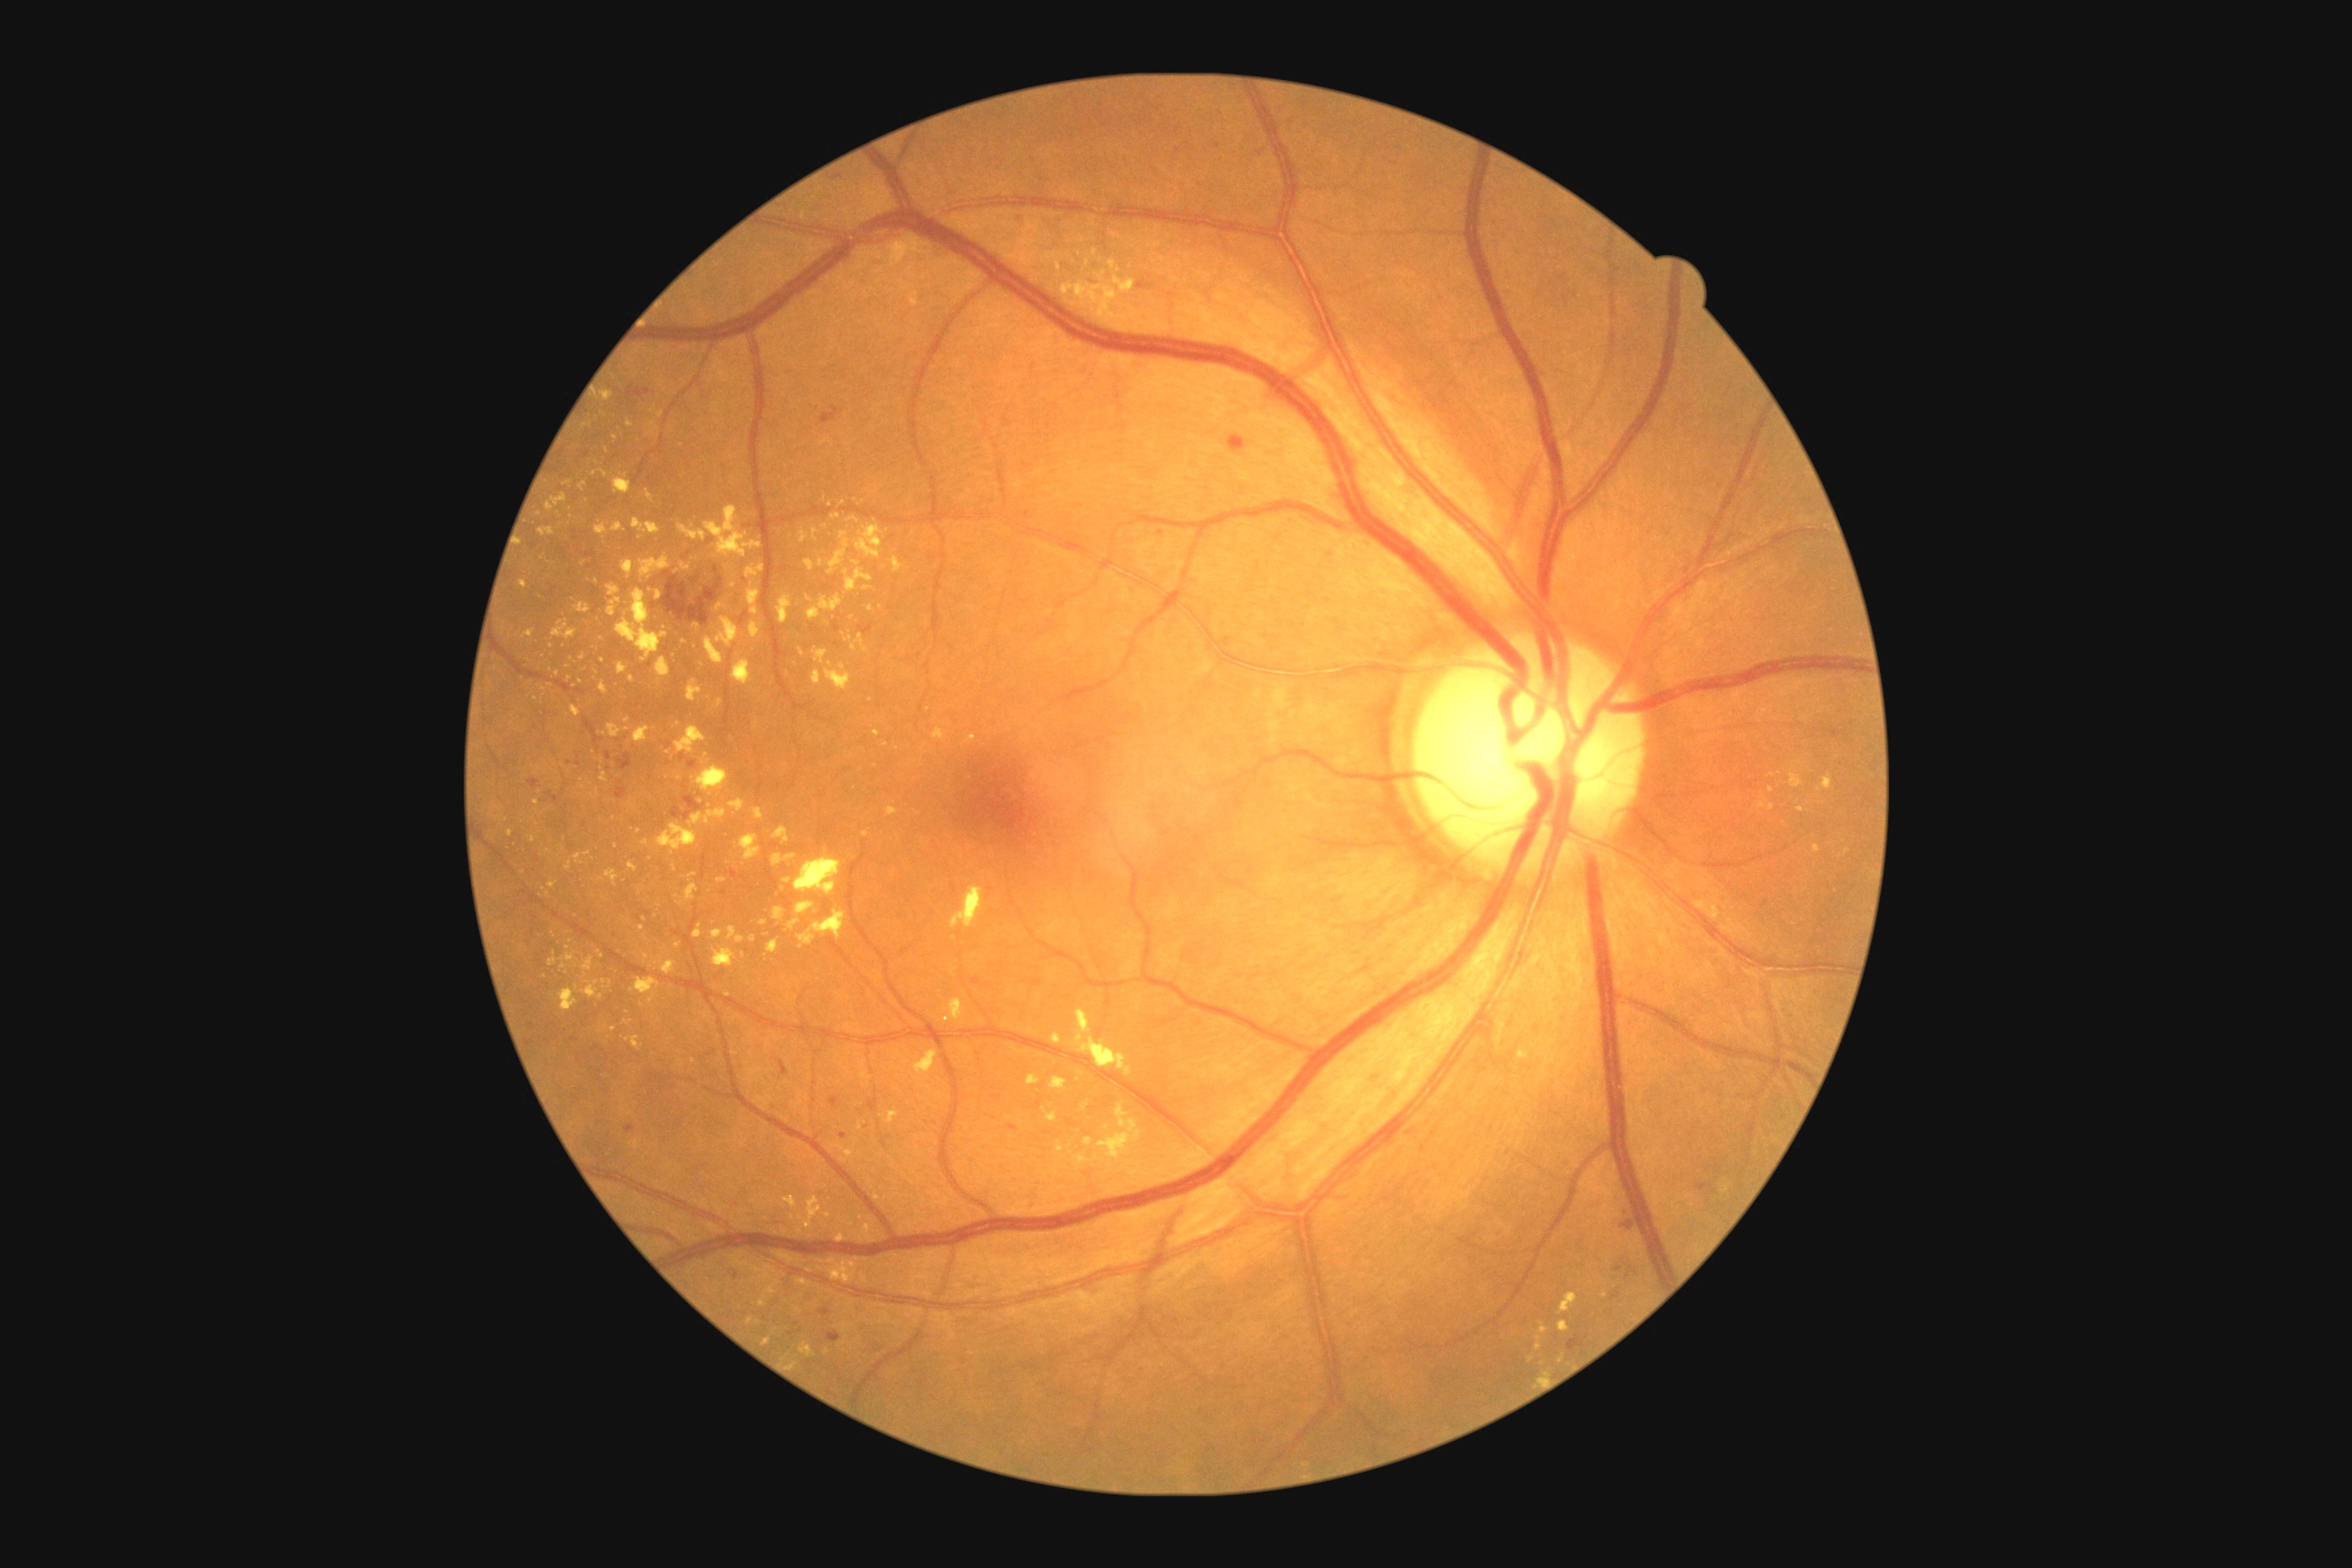
Retinopathy grade is 2
A subset of detected lesions:
hard exudates (partial): 600 767 609 783; 520 580 529 589; 805 1195 821 1230; 760 921 769 926; 774 827 790 843; 1560 1322 1571 1333; 794 858 841 897; 760 1286 778 1308; 716 603 725 611; 729 799 745 812
Smaller hard exudates around Point(614, 1030); Point(661, 414); Point(568, 948); Point(871, 1183); Point(1075, 262); Point(796, 1365); Point(600, 998); Point(753, 939); Point(1150, 245)